Pediatric wide-field fundus photograph; Clarity RetCam 3, 130° FOV:
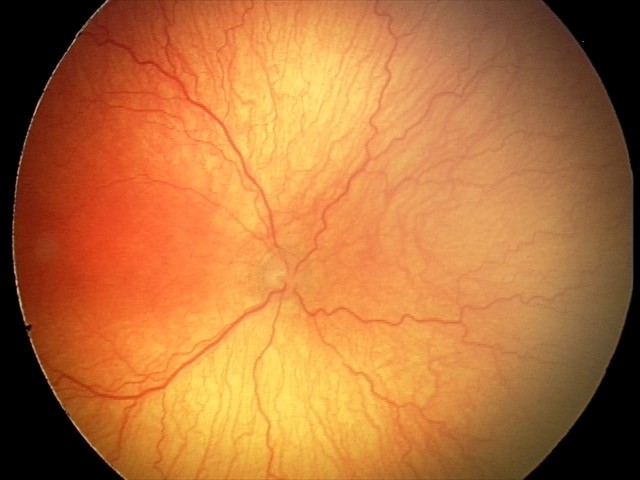
Screening series with aggressive retinopathy of prematurity — rapidly progressive severe ROP with prominent plus disease, often without classic stage progression. Plus disease was diagnosed.